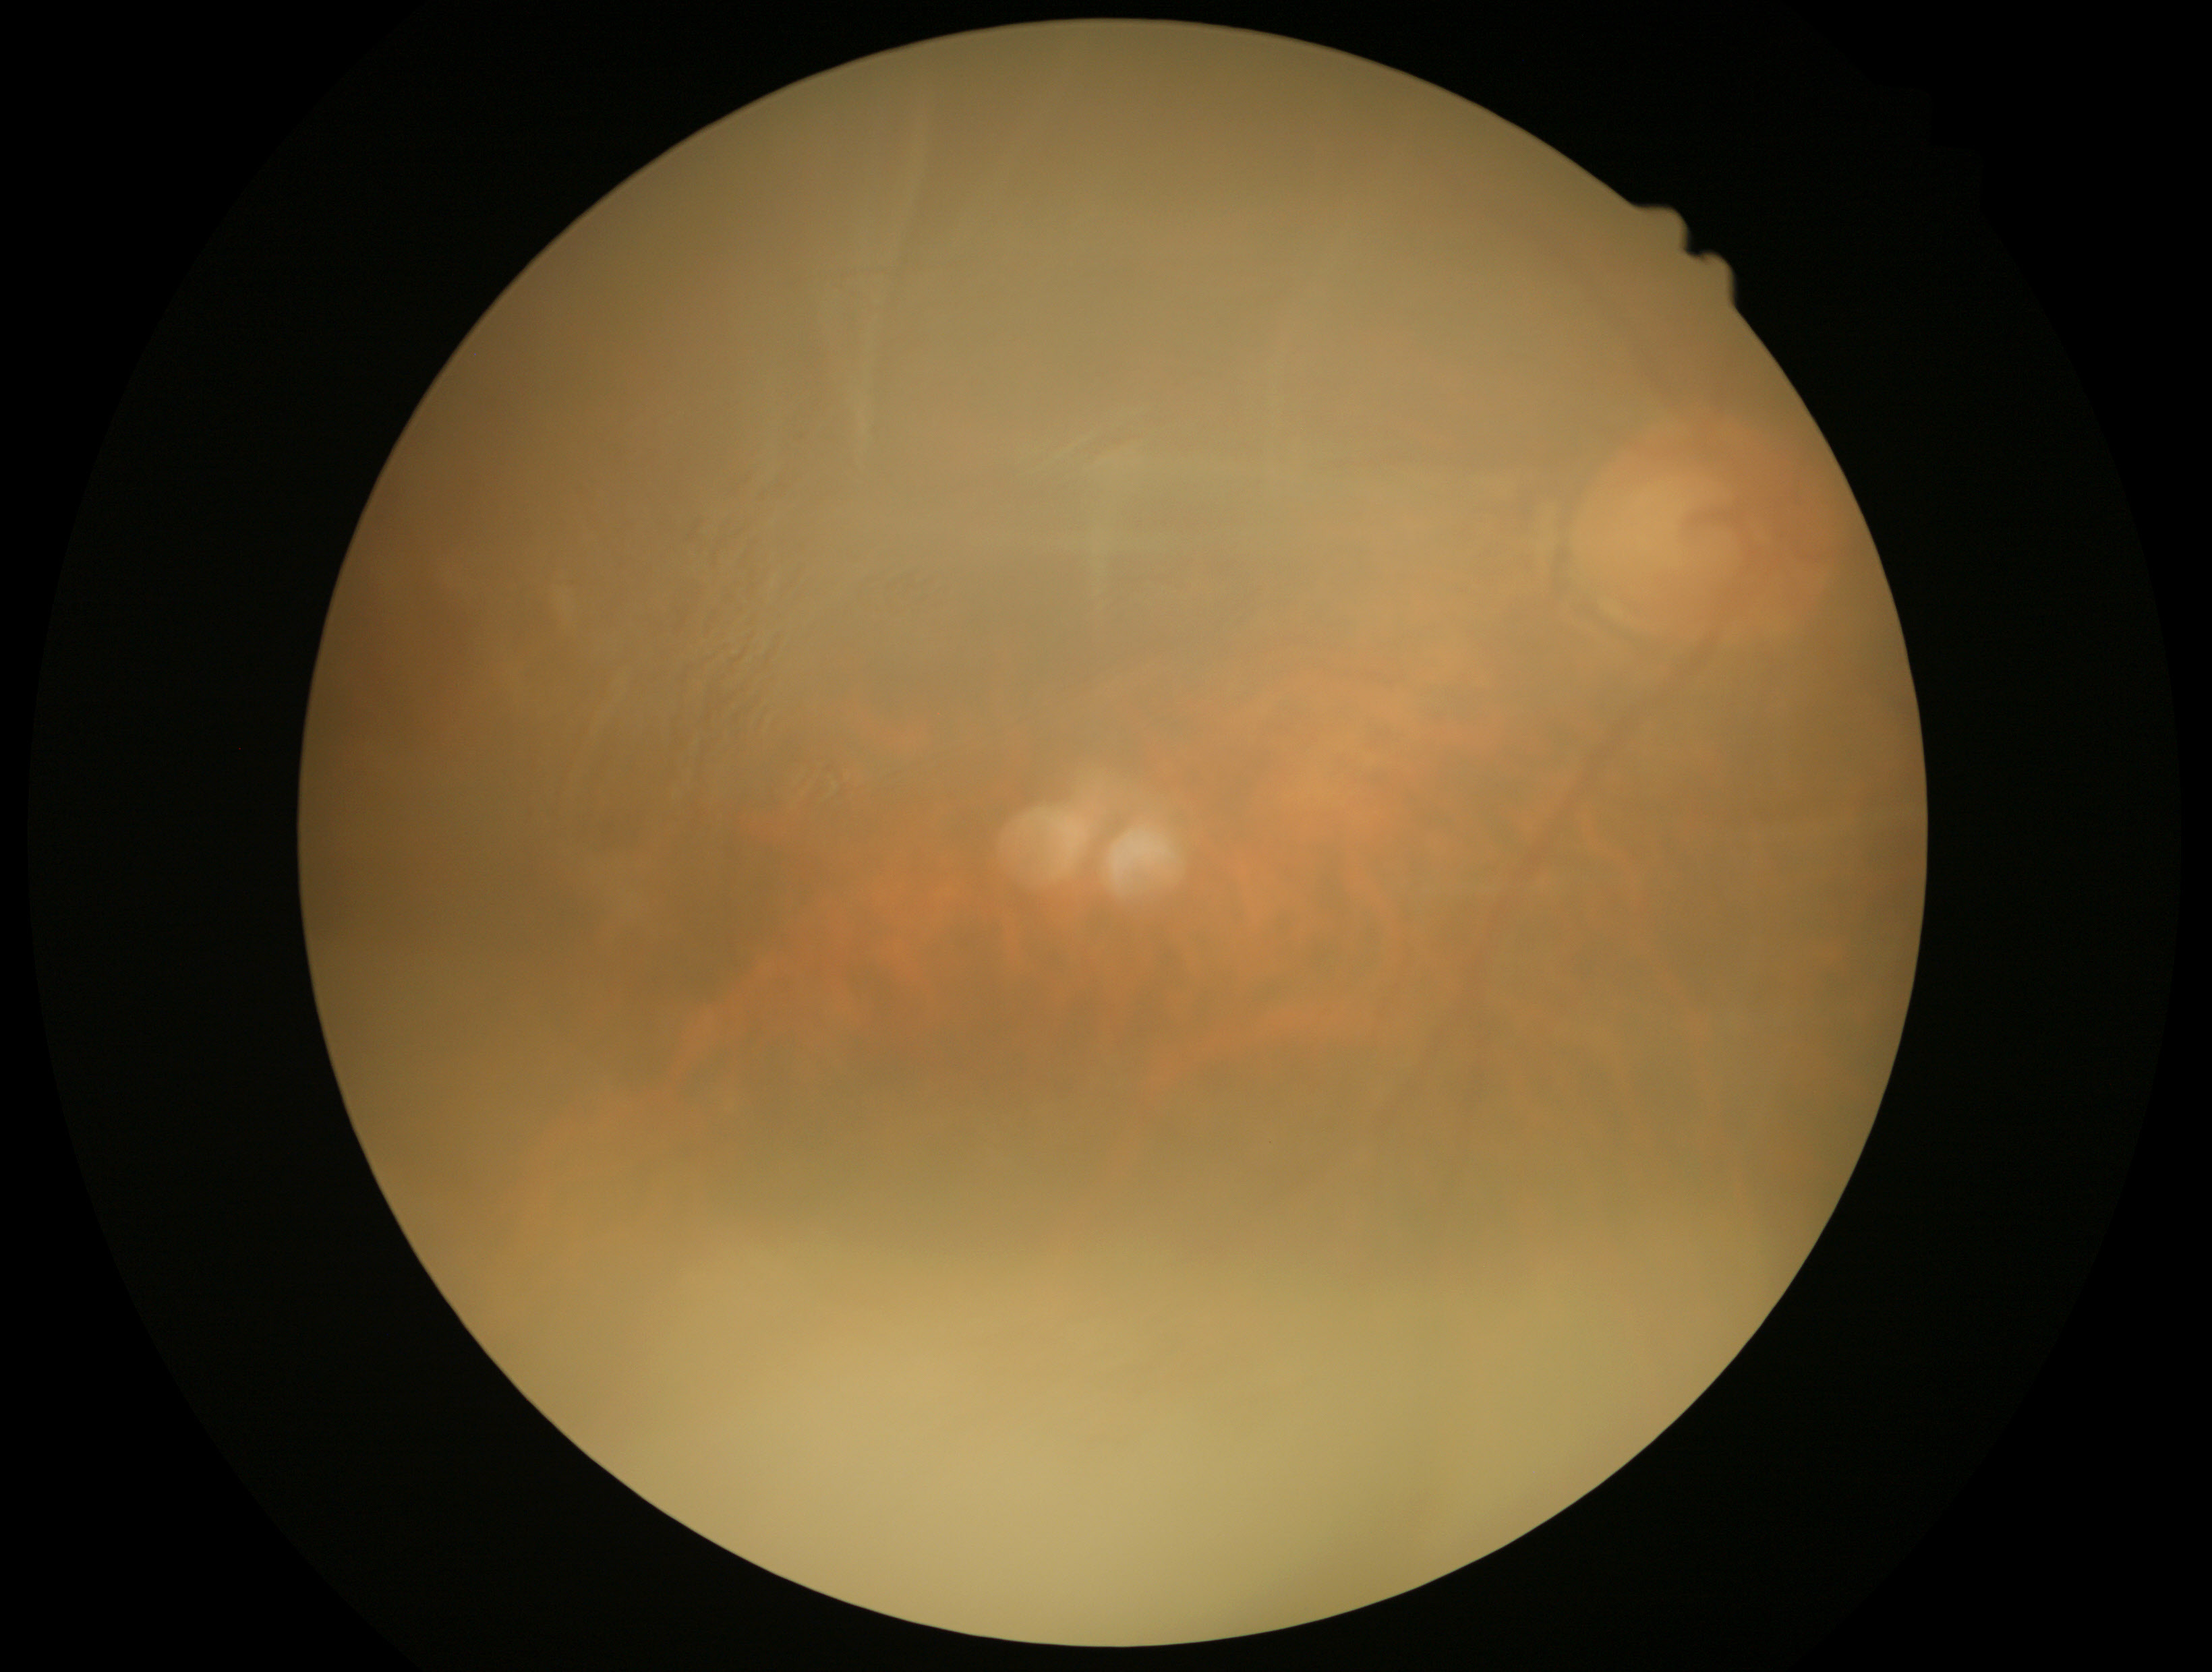 image quality: insufficient for DR assessment; DR grade: ungradable due to poor image quality.